2212 by 1672 pixels, color fundus image.
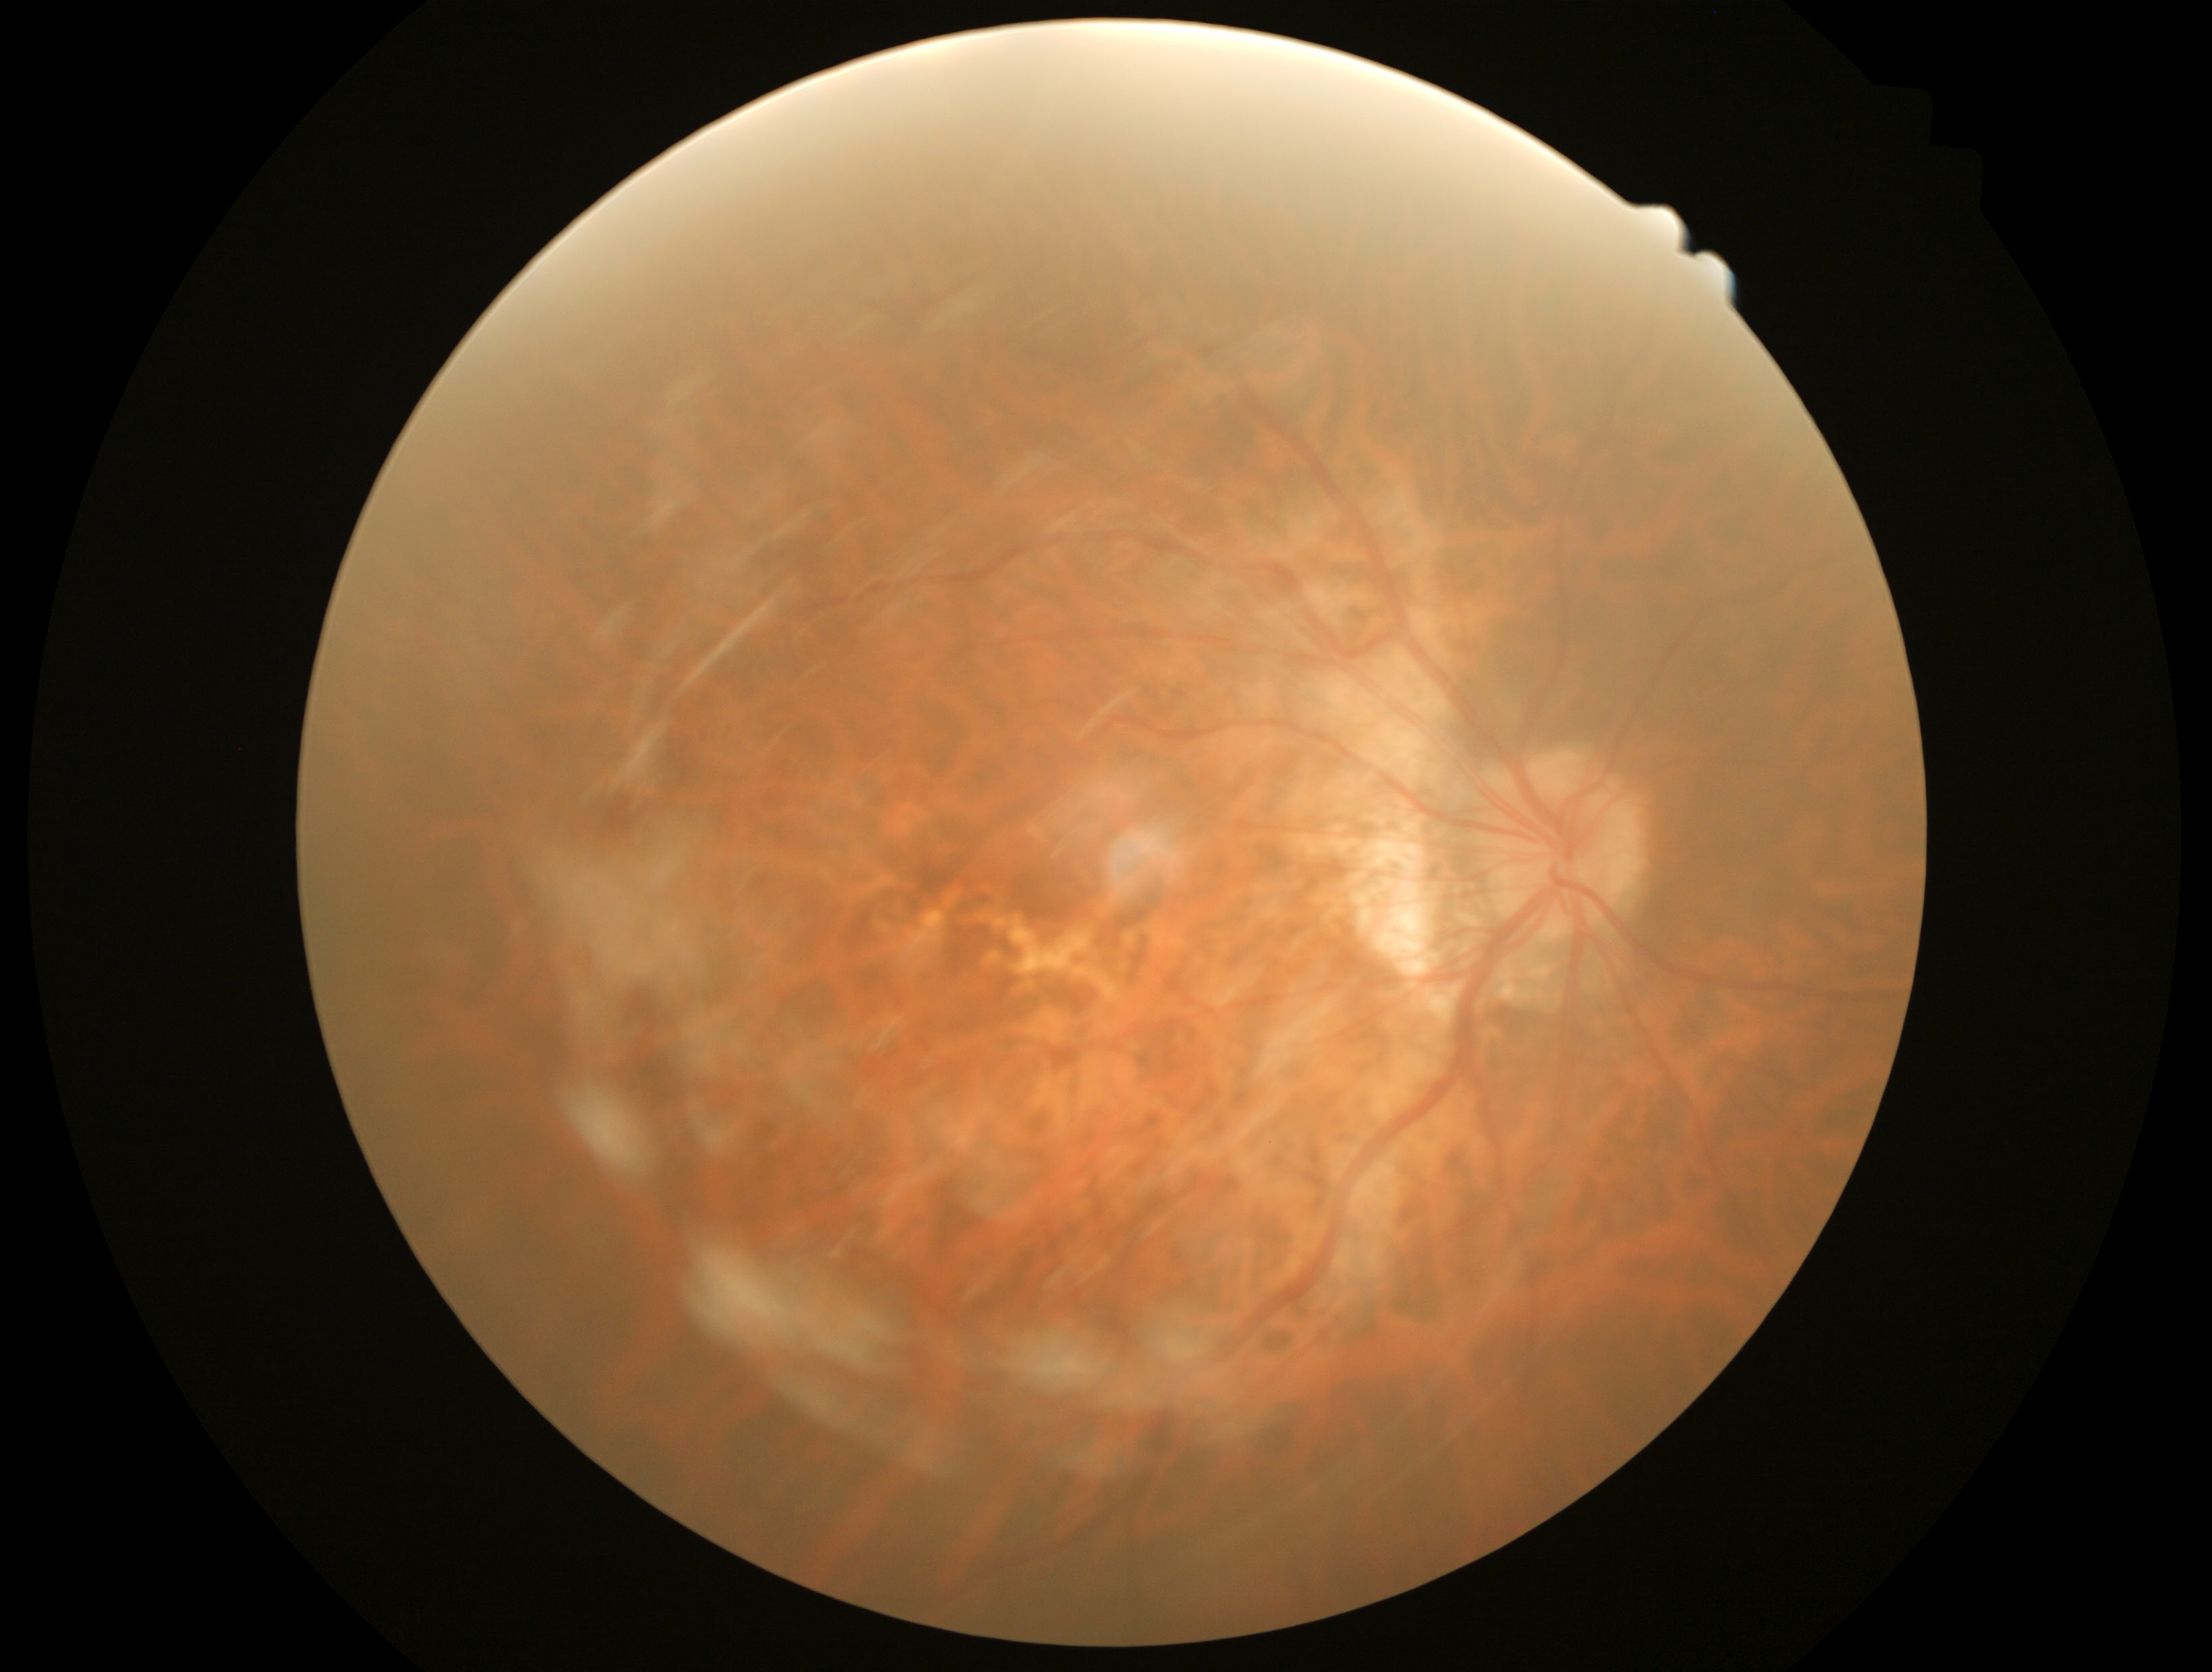

No signs of diabetic retinopathy.
Diabetic retinopathy (DR): 0/4.